Acquired with a NIDEK AFC-230 — 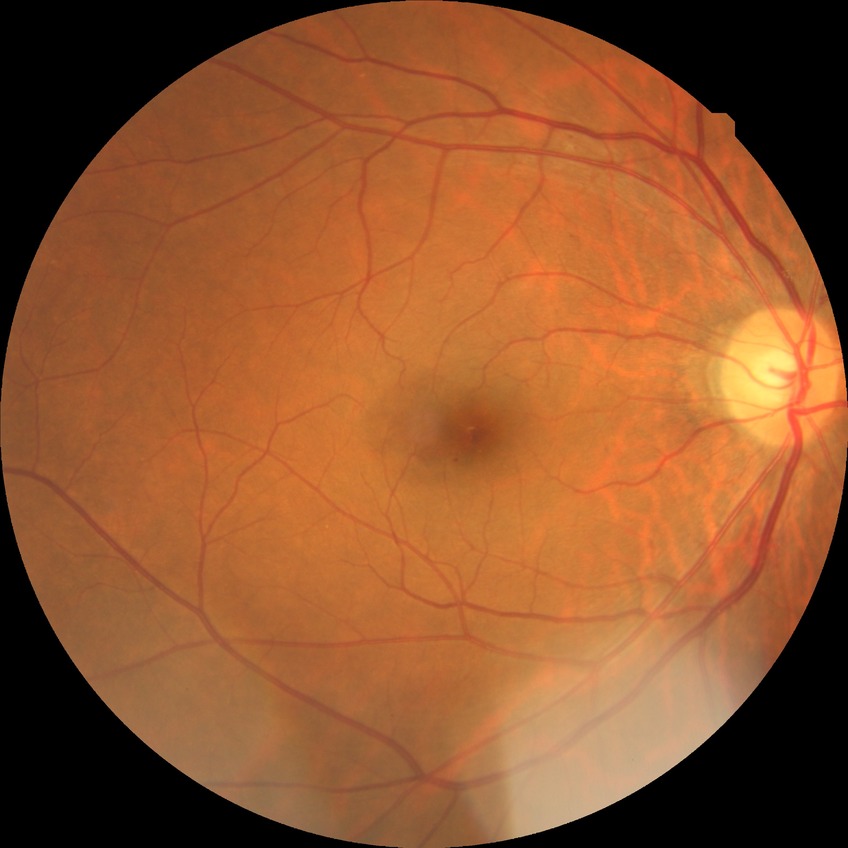
Diabetic retinopathy (DR): SDR (simple diabetic retinopathy).
DR class: non-proliferative diabetic retinopathy.